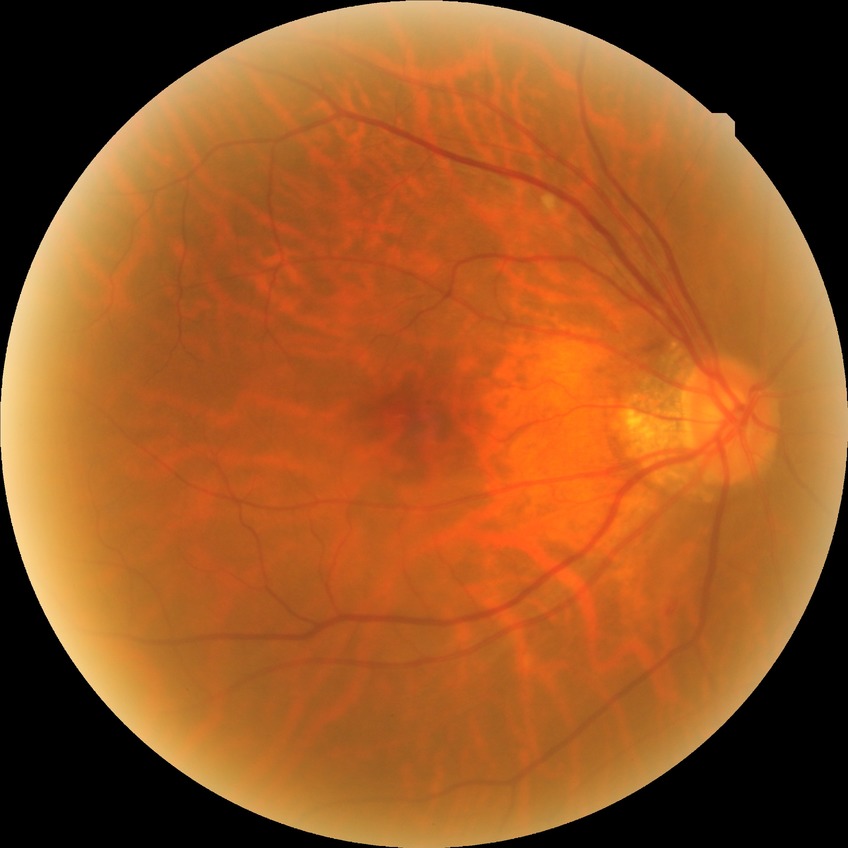

Diabetic retinopathy (DR): NDR (no diabetic retinopathy).